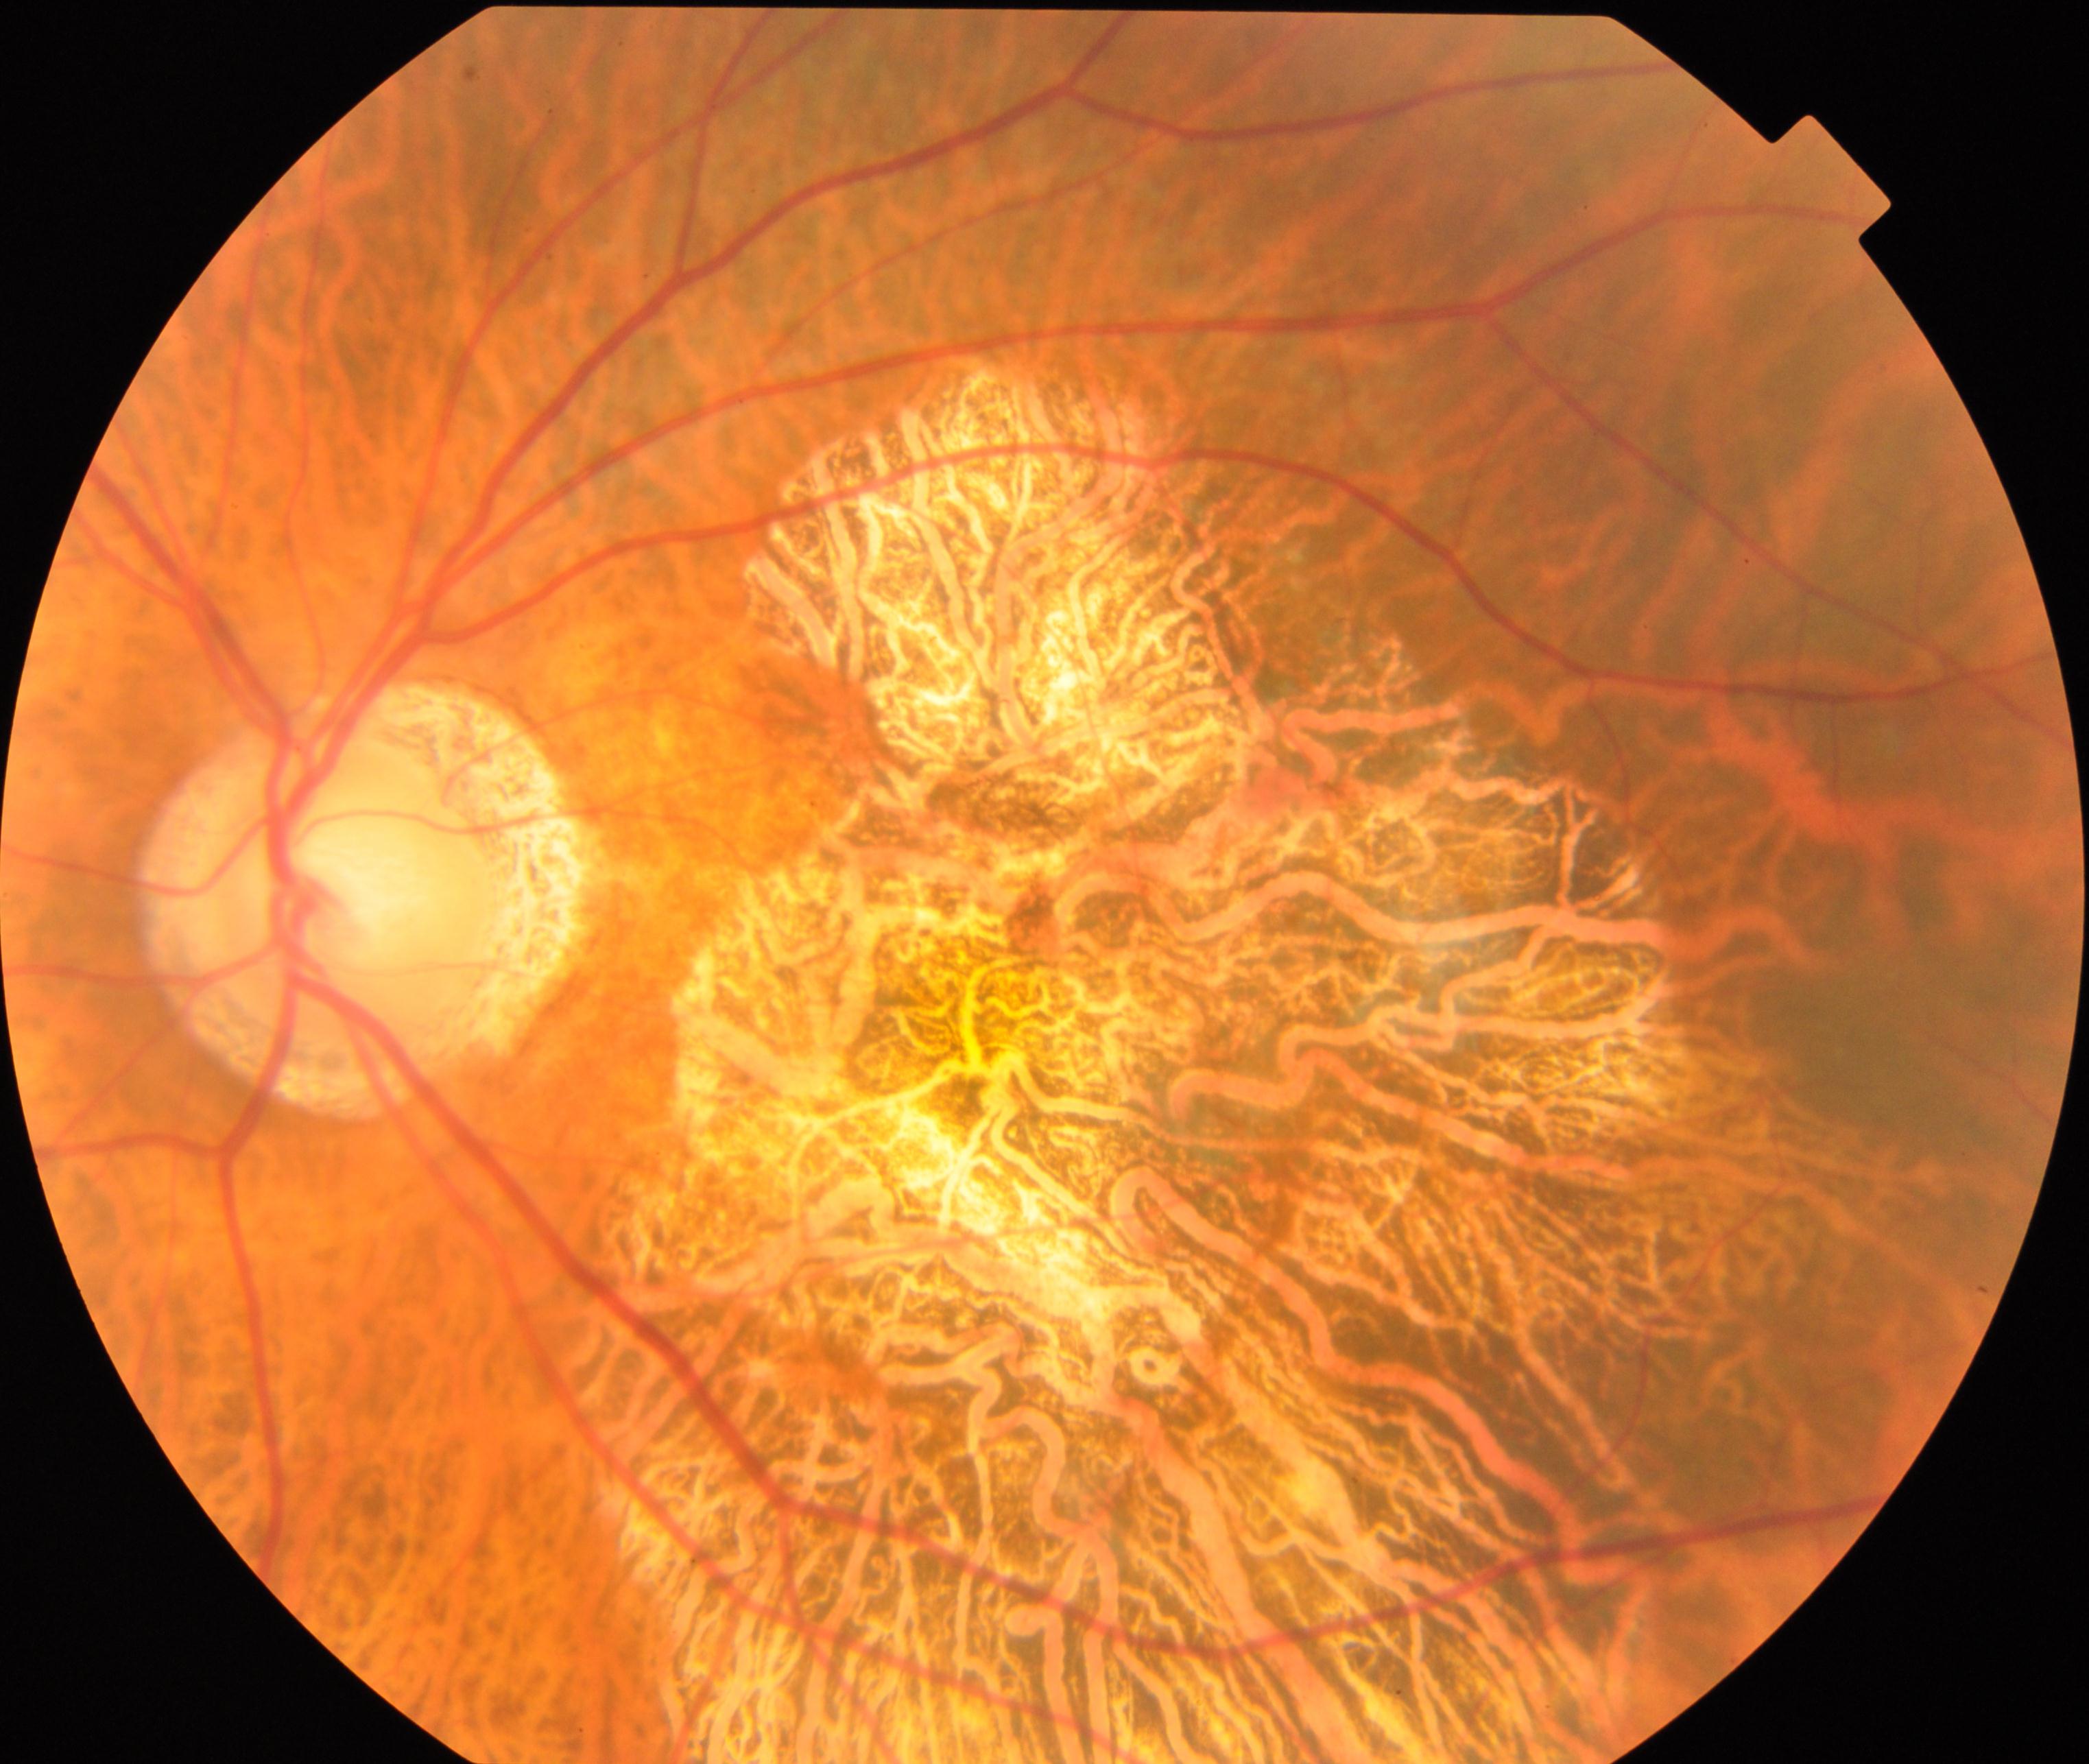

Diagnosis: pathological myopia.